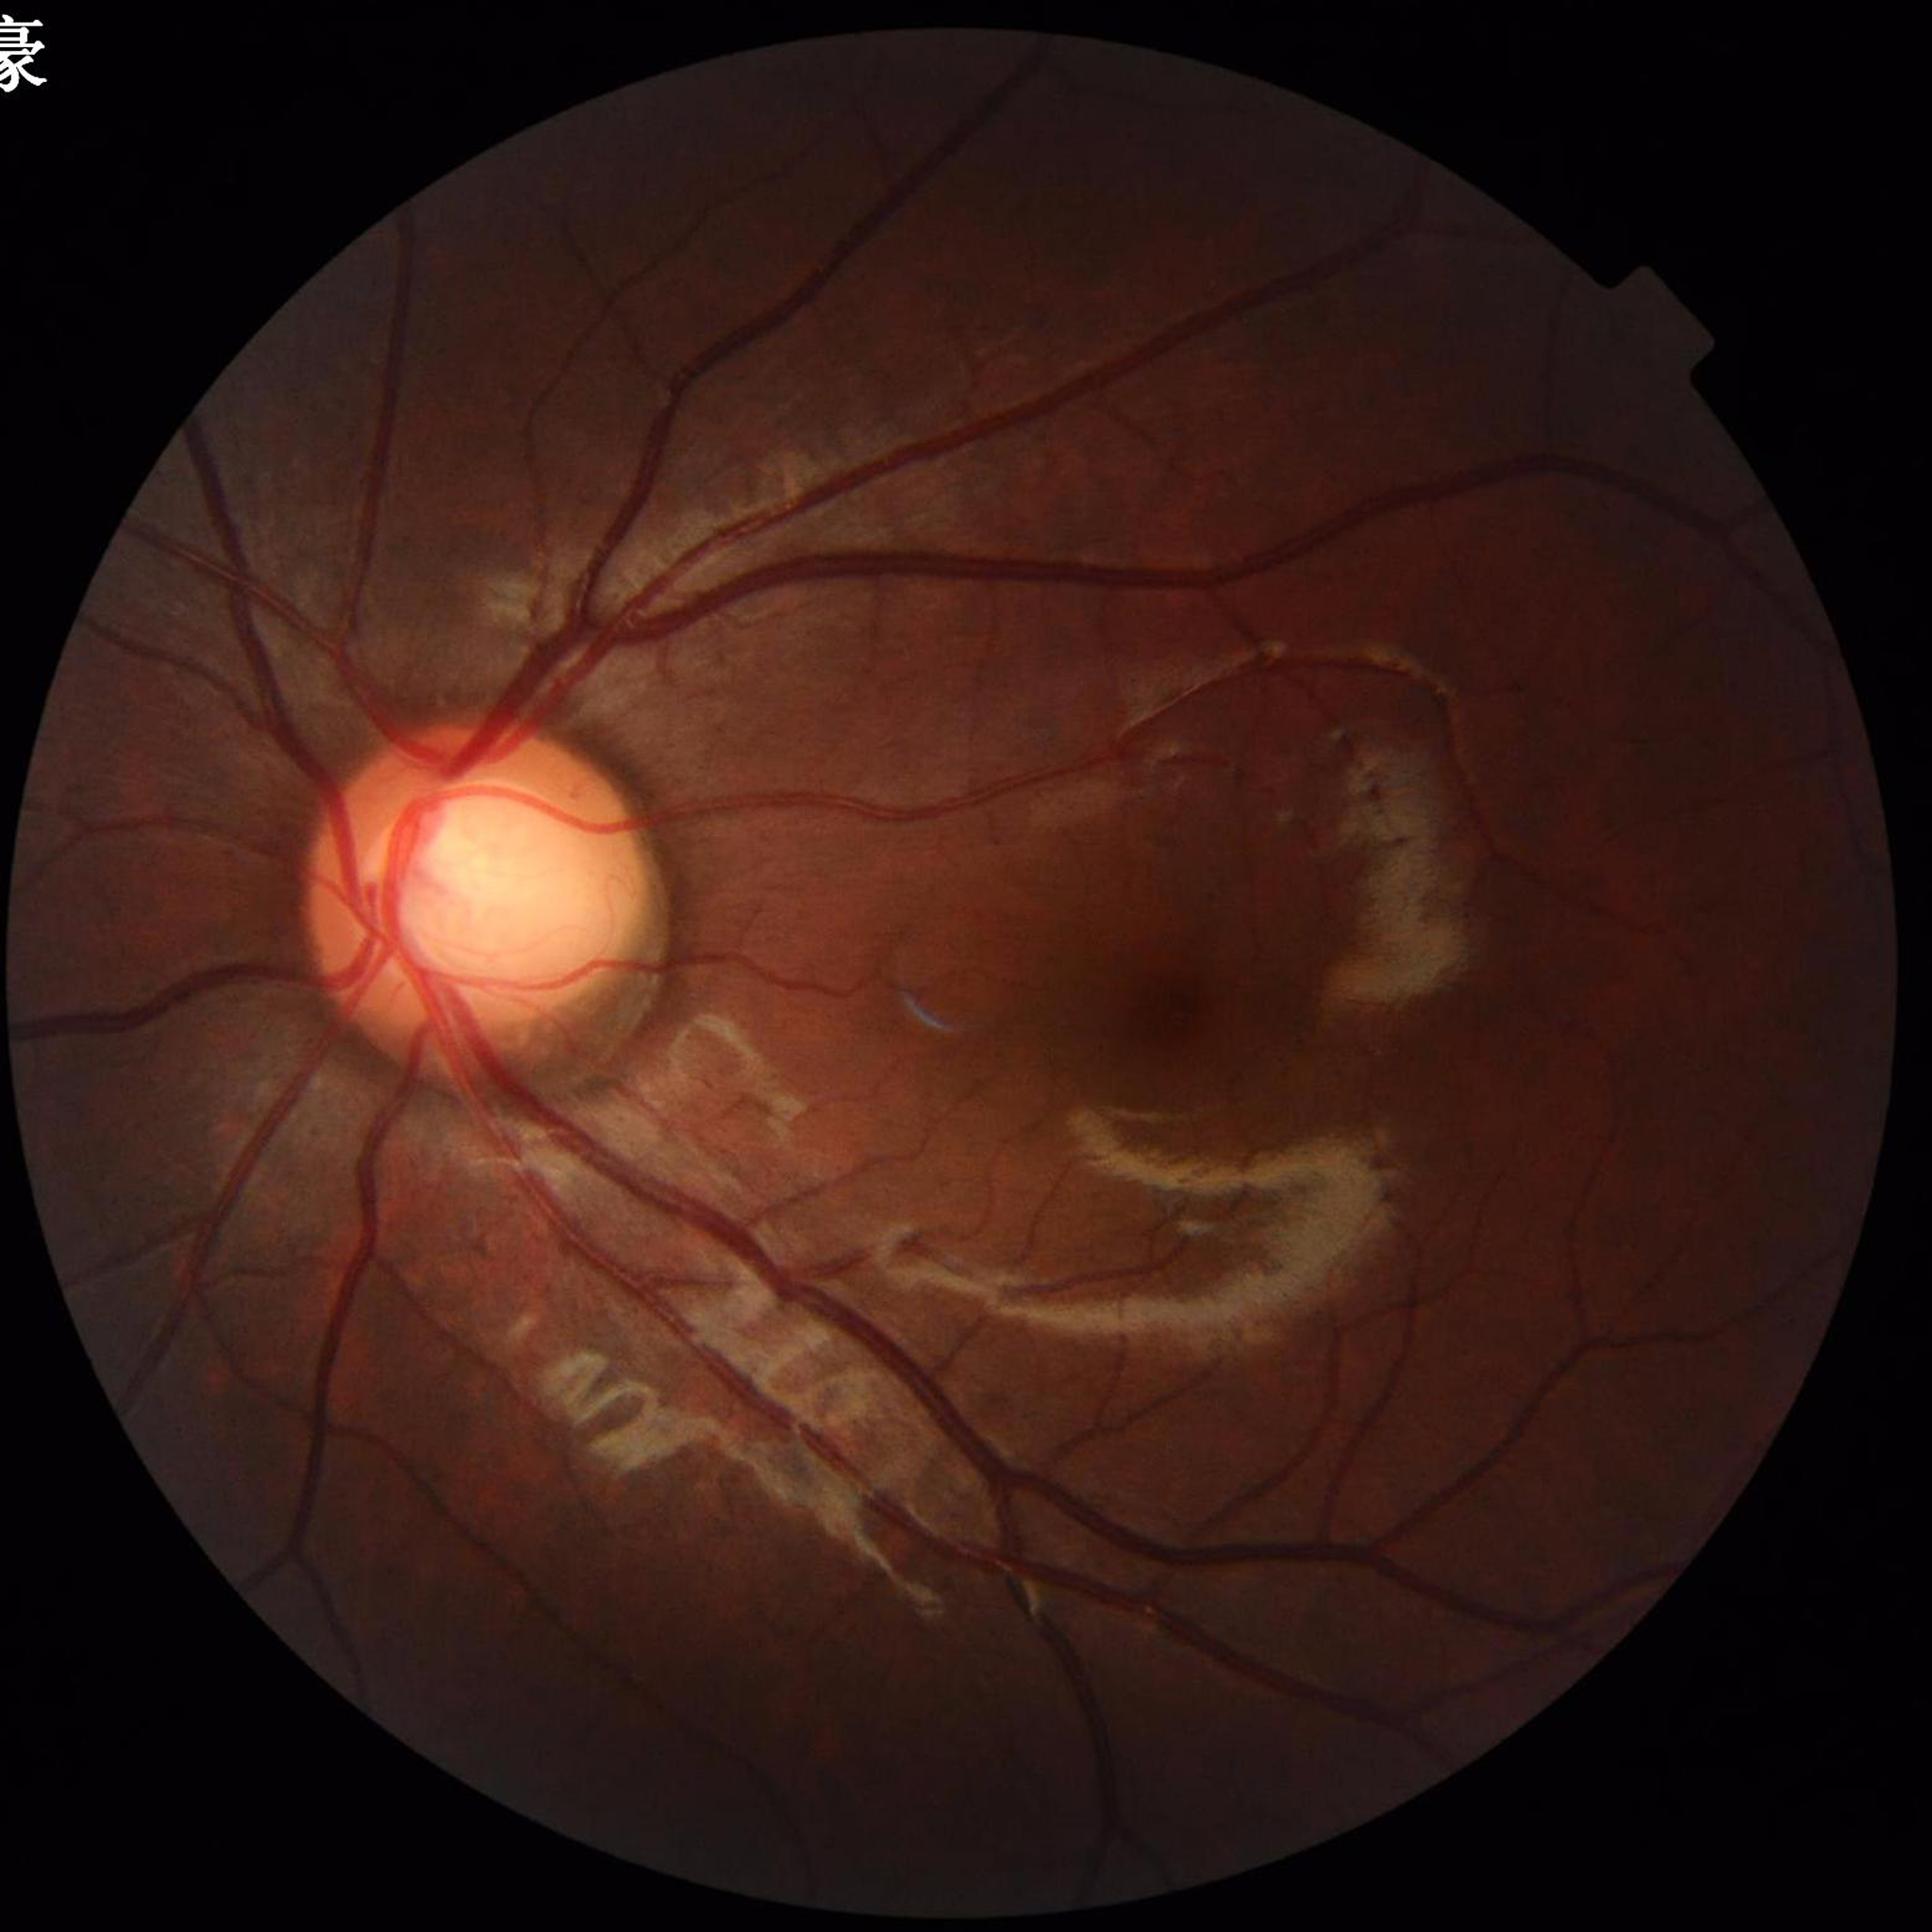
Quality: good.
Eye affected by glaucoma.